2352x1568px
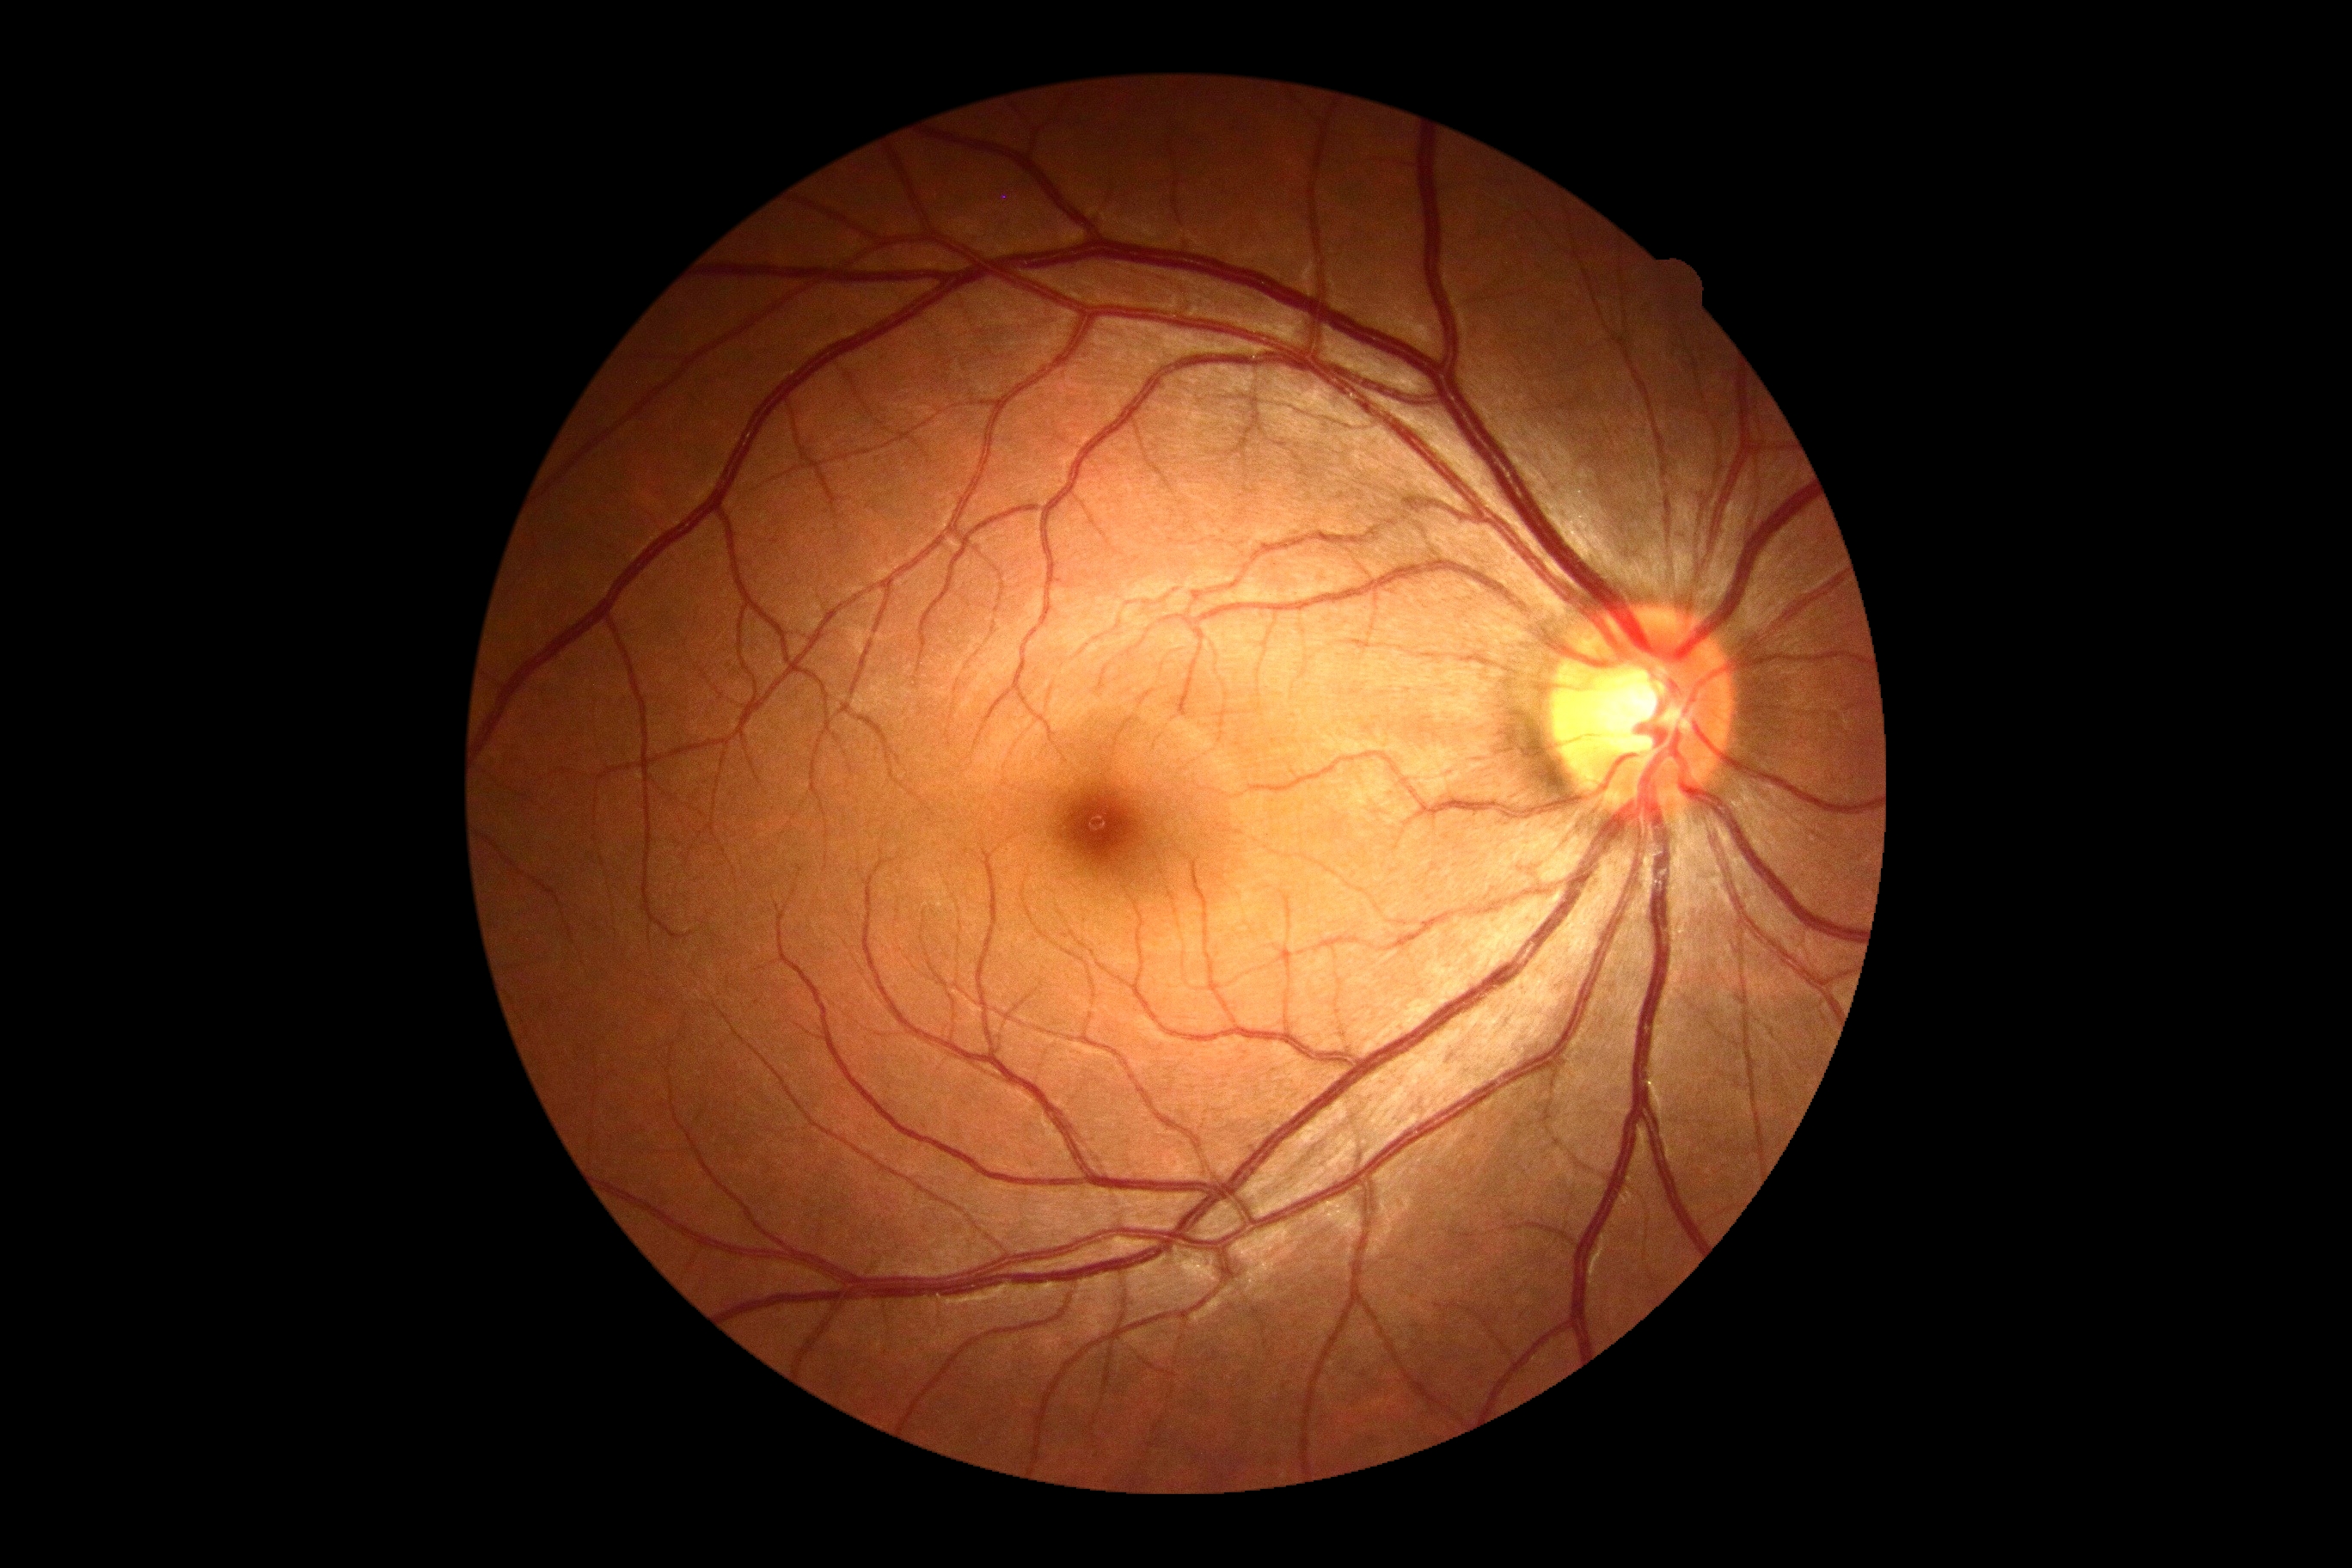

{"dr_grade": "0 (no apparent retinopathy)"}